Color fundus photograph centered on the optic disc · captured on a Topcon TRC retinal camera · 322 x 322 pixels: 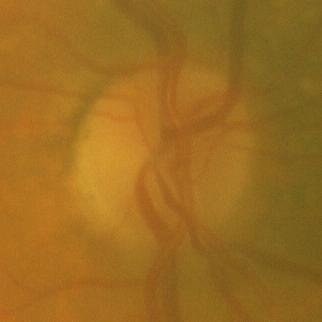

Glaucoma assessment = no glaucomatous optic neuropathy.